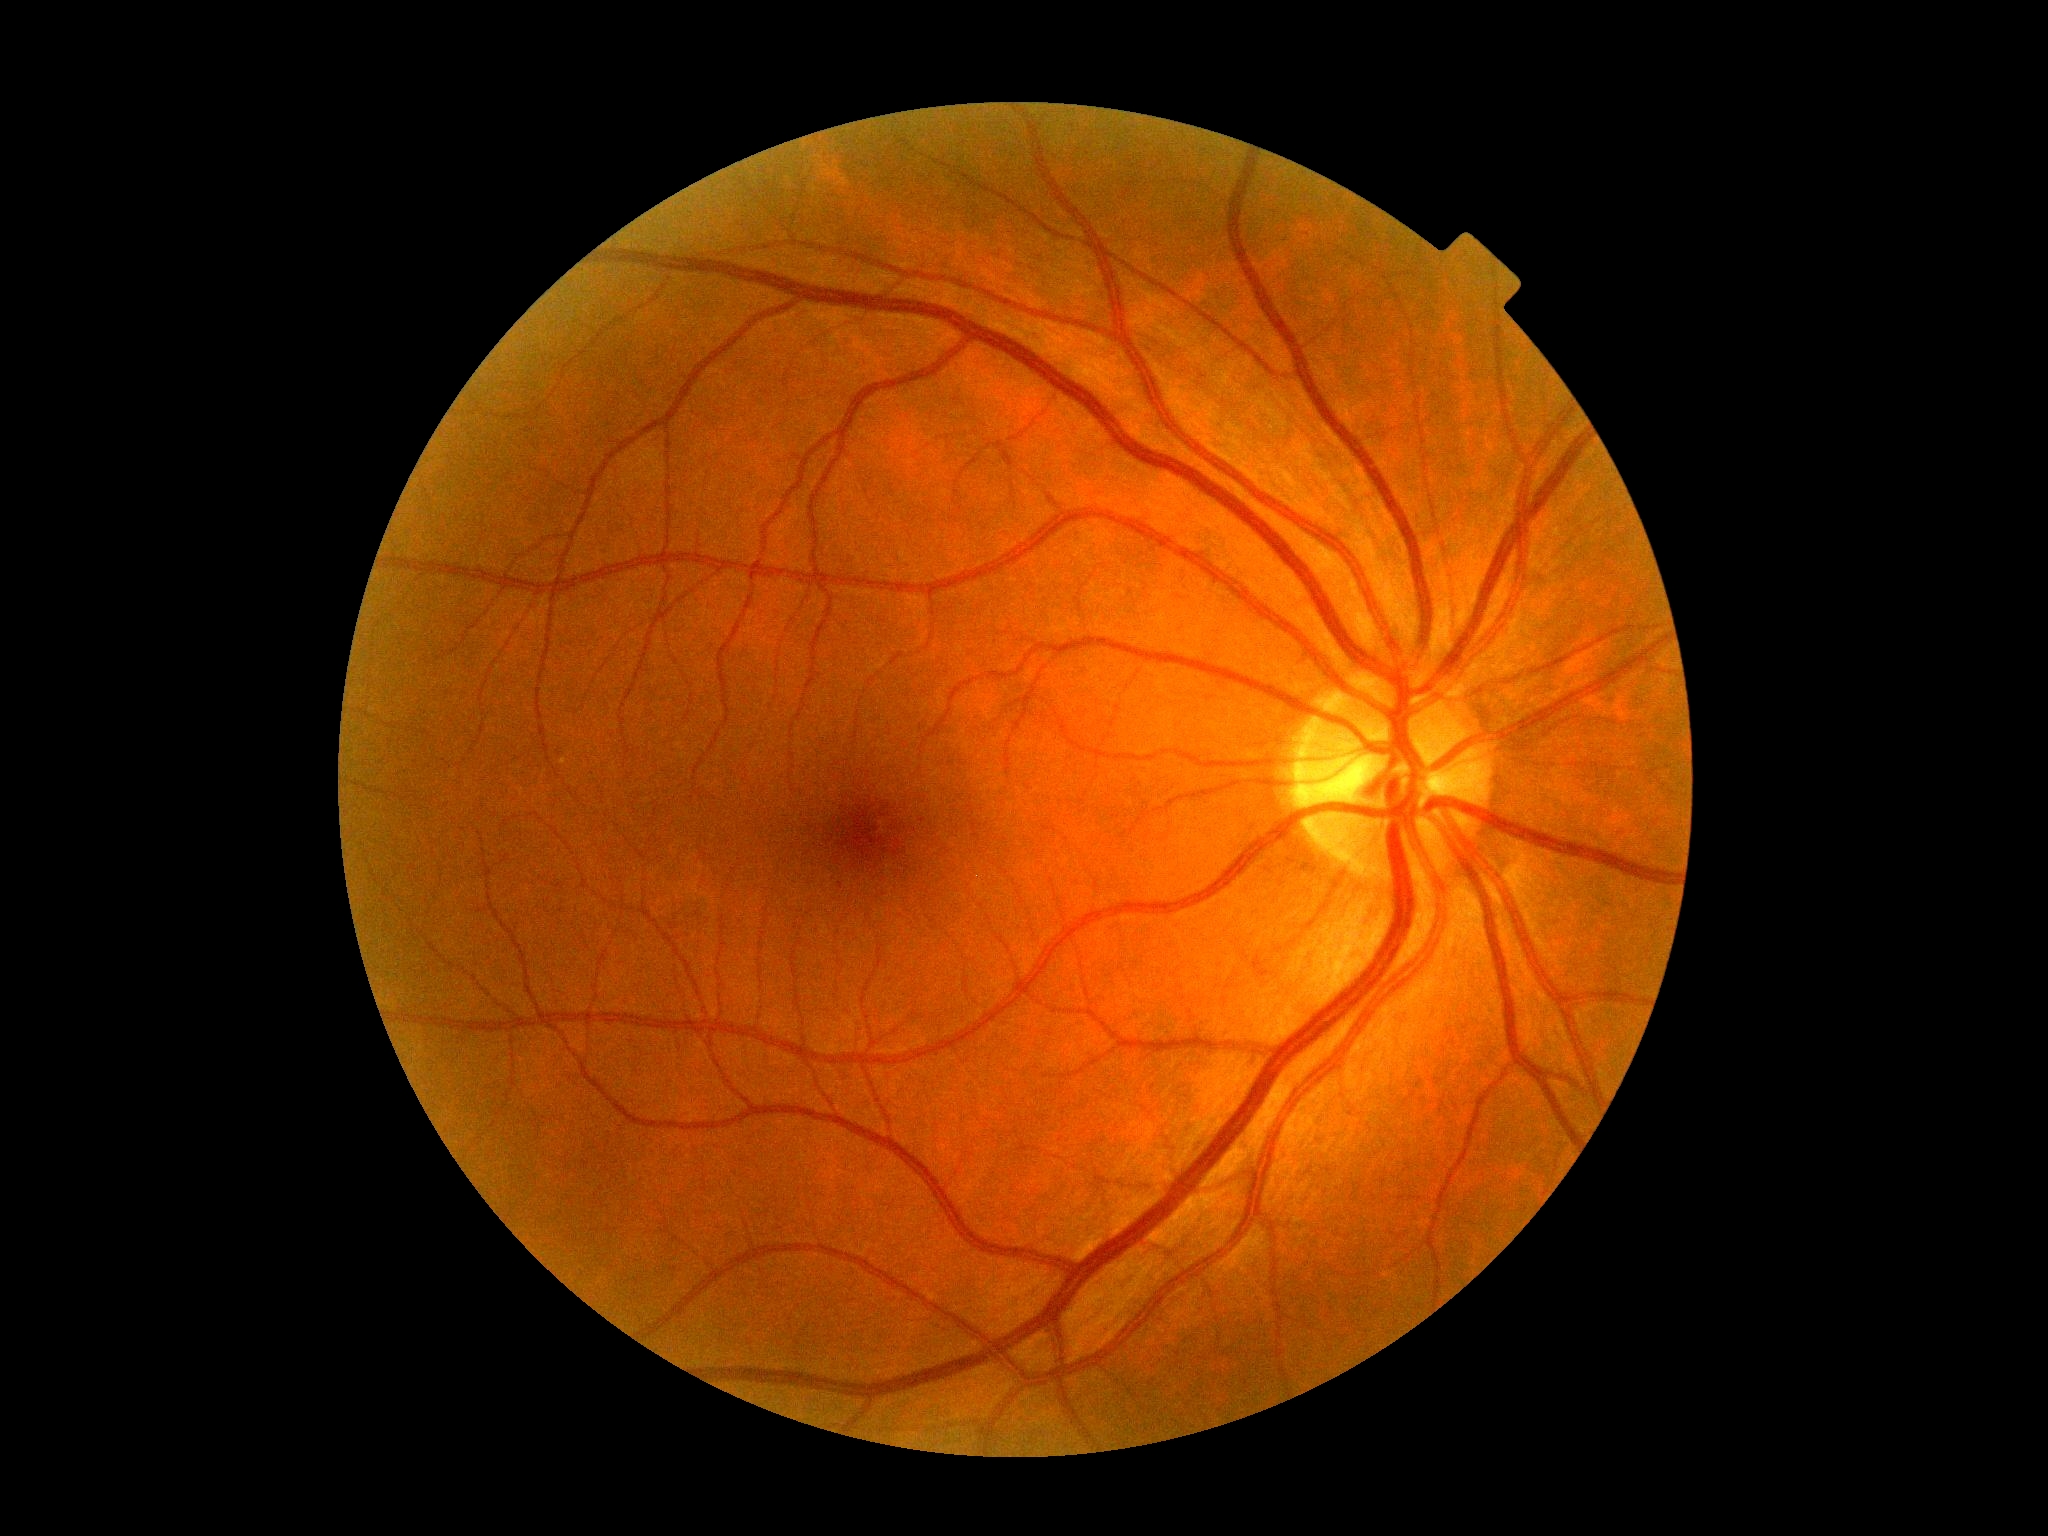
DR impression: no DR findings; DR: no apparent retinopathy (grade 0).